Phoenix ICON, 100° FOV. Infant wide-field retinal image
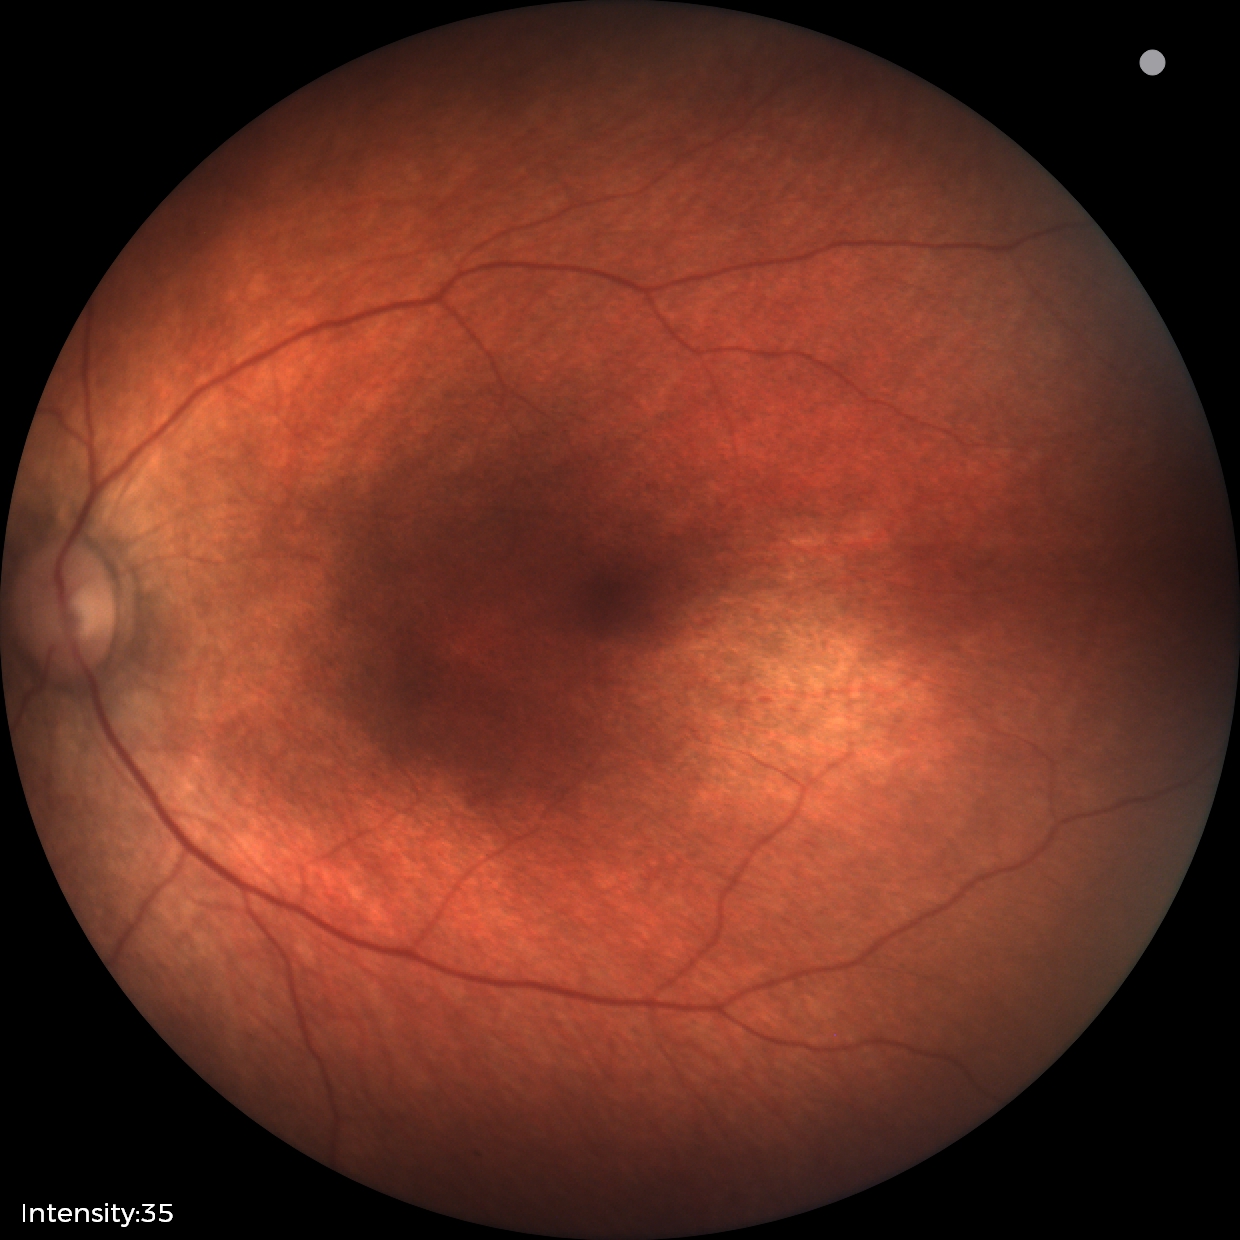
Screening examination diagnosed as physiological.